Pediatric retinal photograph (wide-field) — 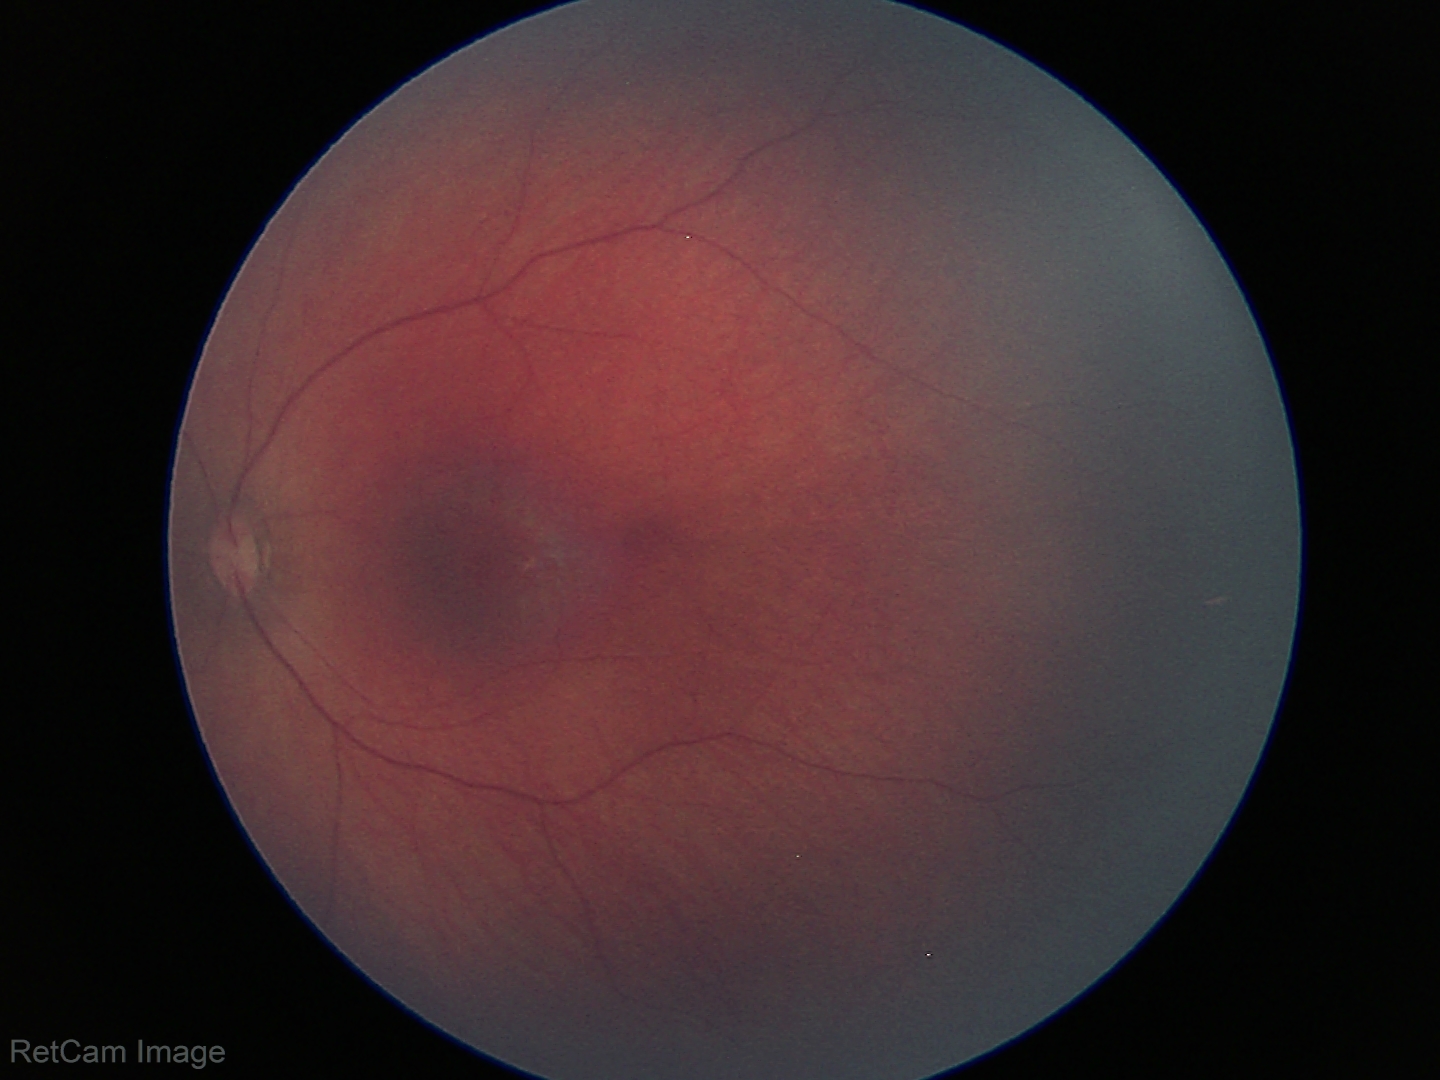
Screening examination with no abnormal retinal findings.